Graded on the modified Davis scale. NIDEK AFC-230
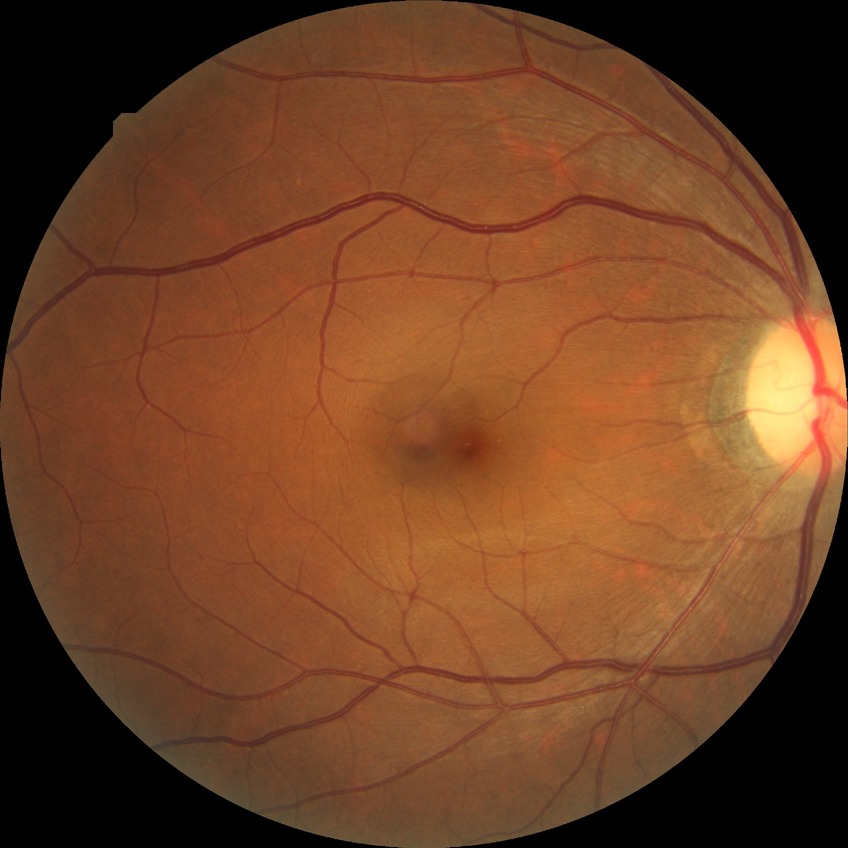 Modified Davis grading is no diabetic retinopathy.